412x310px; retinal fundus photograph; 45-degree field of view: 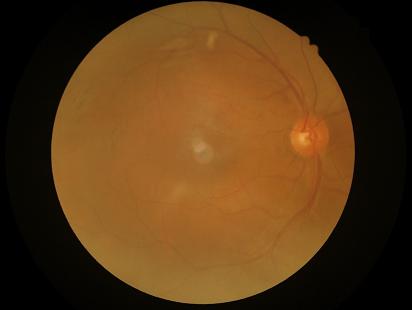 The image is blurry. Vessels and details are readily distinguishable. Image quality is inadequate for diagnostic use. Even illumination with no color cast.